Color fundus photograph, 45-degree field of view, 2346 x 1568 pixels — 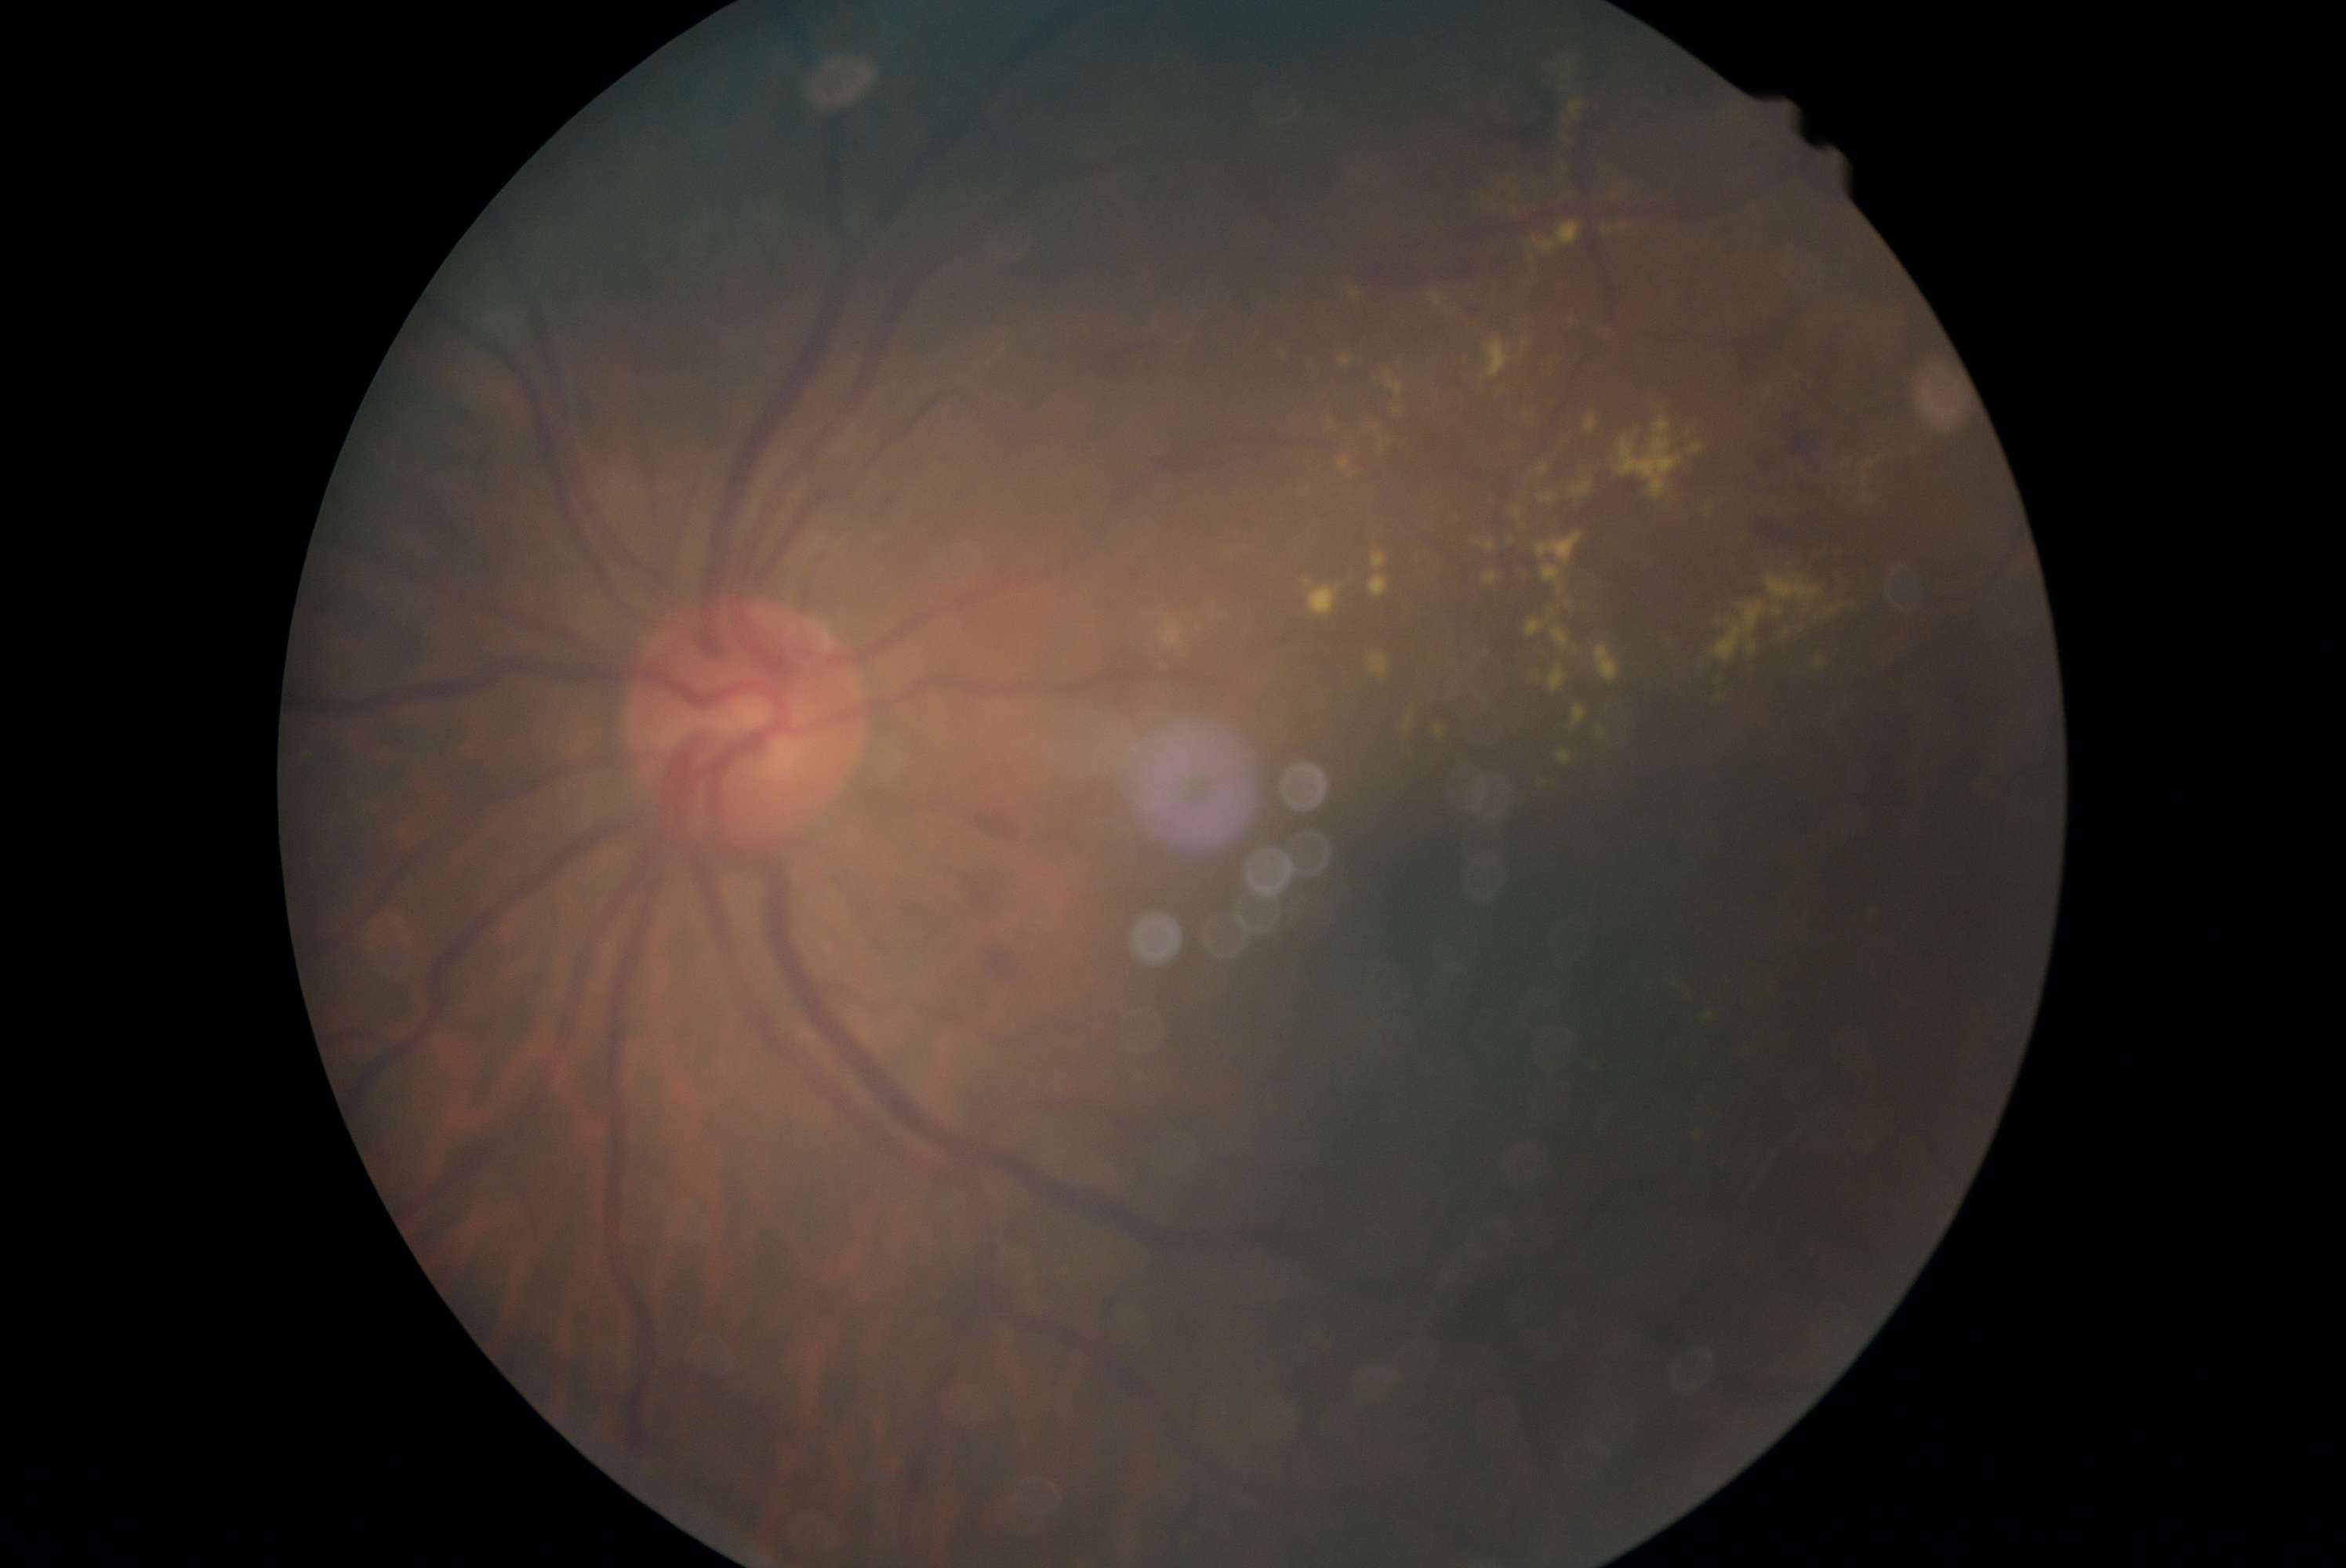 Diabetic retinopathy is moderate NPDR (grade 2).